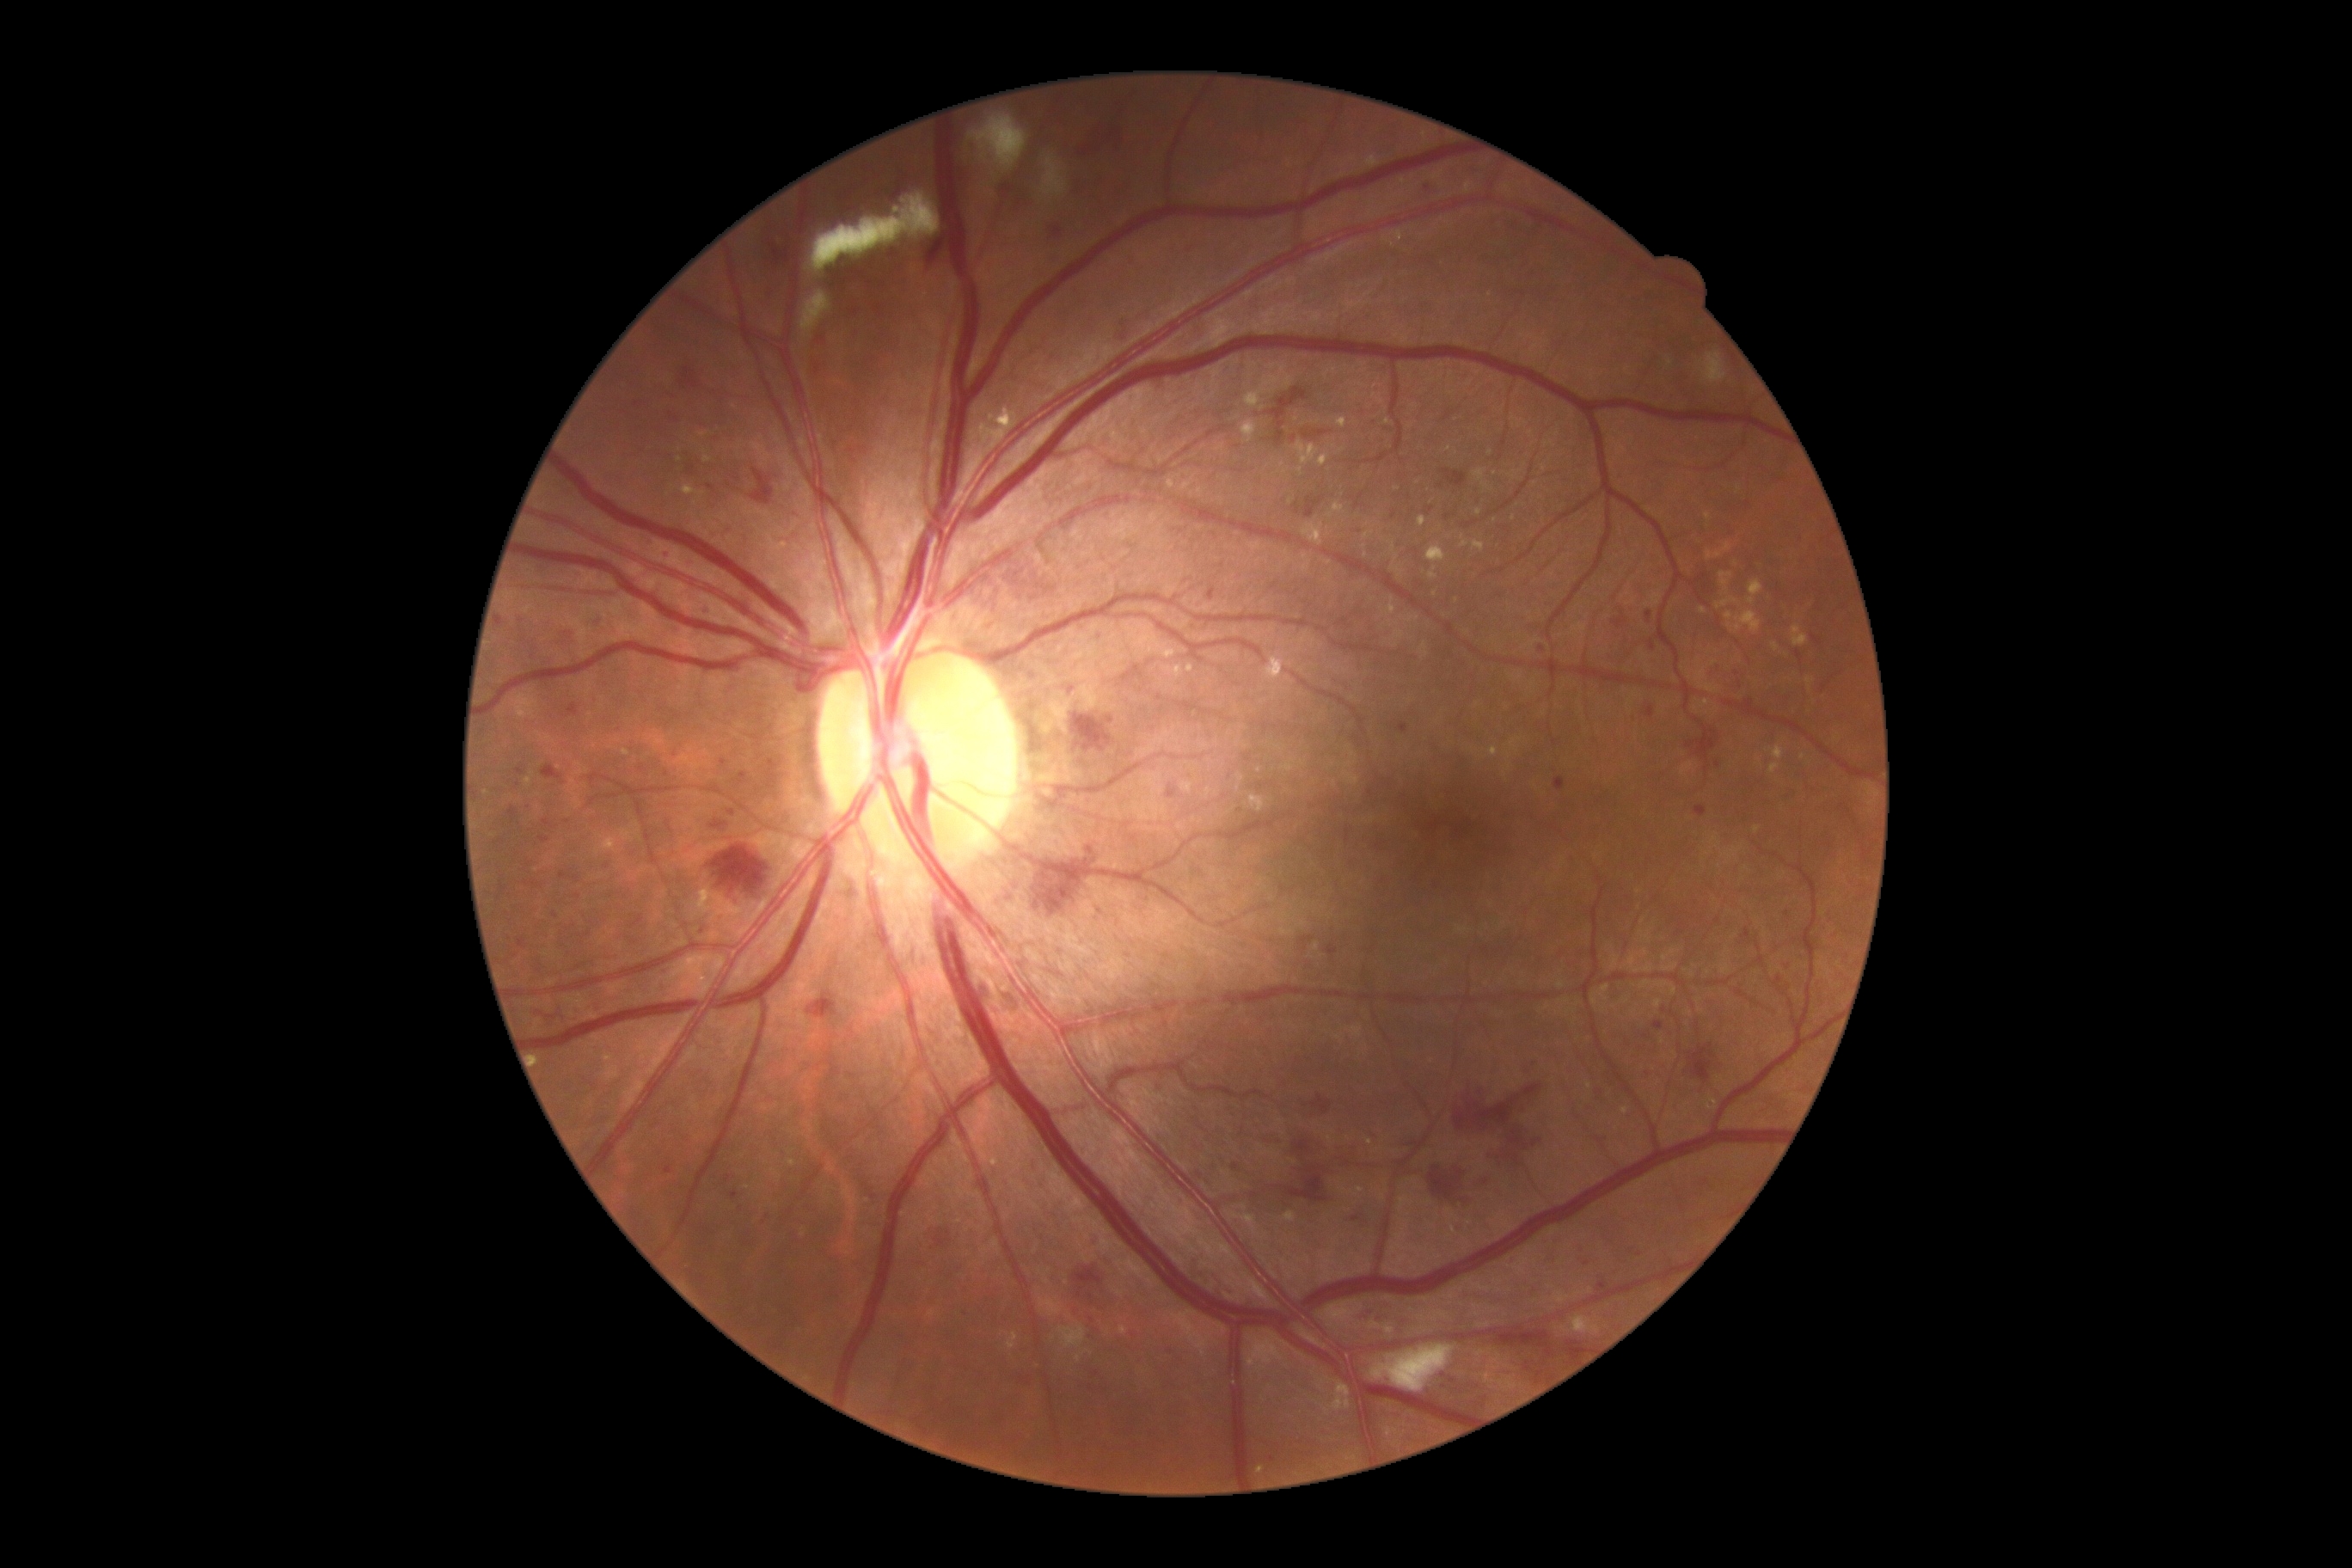 Diabetic retinopathy grade: 3.
Microaneurysms include 680/367/701/389; 707/484/716/493; 496/616/505/627; 542/821/558/830; 594/618/608/630; 1696/807/1706/818; 601/575/608/585; 1352/1216/1361/1223; 1091/1240/1098/1253; 1294/1141/1311/1155; 732/1192/738/1201.
Microaneurysms (small, approximate centers) near Point(1098, 919); Point(770, 764); Point(1586, 1263); Point(1648, 1036); Point(531, 810); Point(1096, 1374); Point(649, 544); Point(1788, 967); Point(1453, 1381).
Hard exudates include 1736/611/1761/634; 1464/181/1473/193; 1242/420/1258/444; 1430/567/1436/579; 788/1161/797/1167; 699/888/720/902; 608/838/616/845; 1337/417/1347/429; 682/486/704/496; 1706/1096/1718/1112; 1191/309/1237/353; 1701/701/1710/707; 1314/943/1318/952.
Hard exudates (small, approximate centers) near Point(1670, 362); Point(1290, 502); Point(1388, 422); Point(1507, 189); Point(1495, 473).
Soft exudates at 1371/1345/1455/1393; 800/291/831/340; 1060/1325/1086/1349; 1043/159/1067/197; 807/193/941/274; 969/114/1027/173; 1703/353/1727/384.
Soft exudates (small, approximate centers) near Point(984, 156).
Hemorrhages include 1495/1330/1553/1357; 1067/1261/1108/1304; 1459/1079/1547/1134; 809/993/836/1019; 1443/470/1466/487; 1003/993/1022/1015; 1495/1136/1547/1165; 1005/558/1062/604; 750/469/775/505; 1567/1342/1584/1359; 1710/663/1751/692; 1686/726/1718/763; 1034/859/1103/916; 983/983/993/1003.